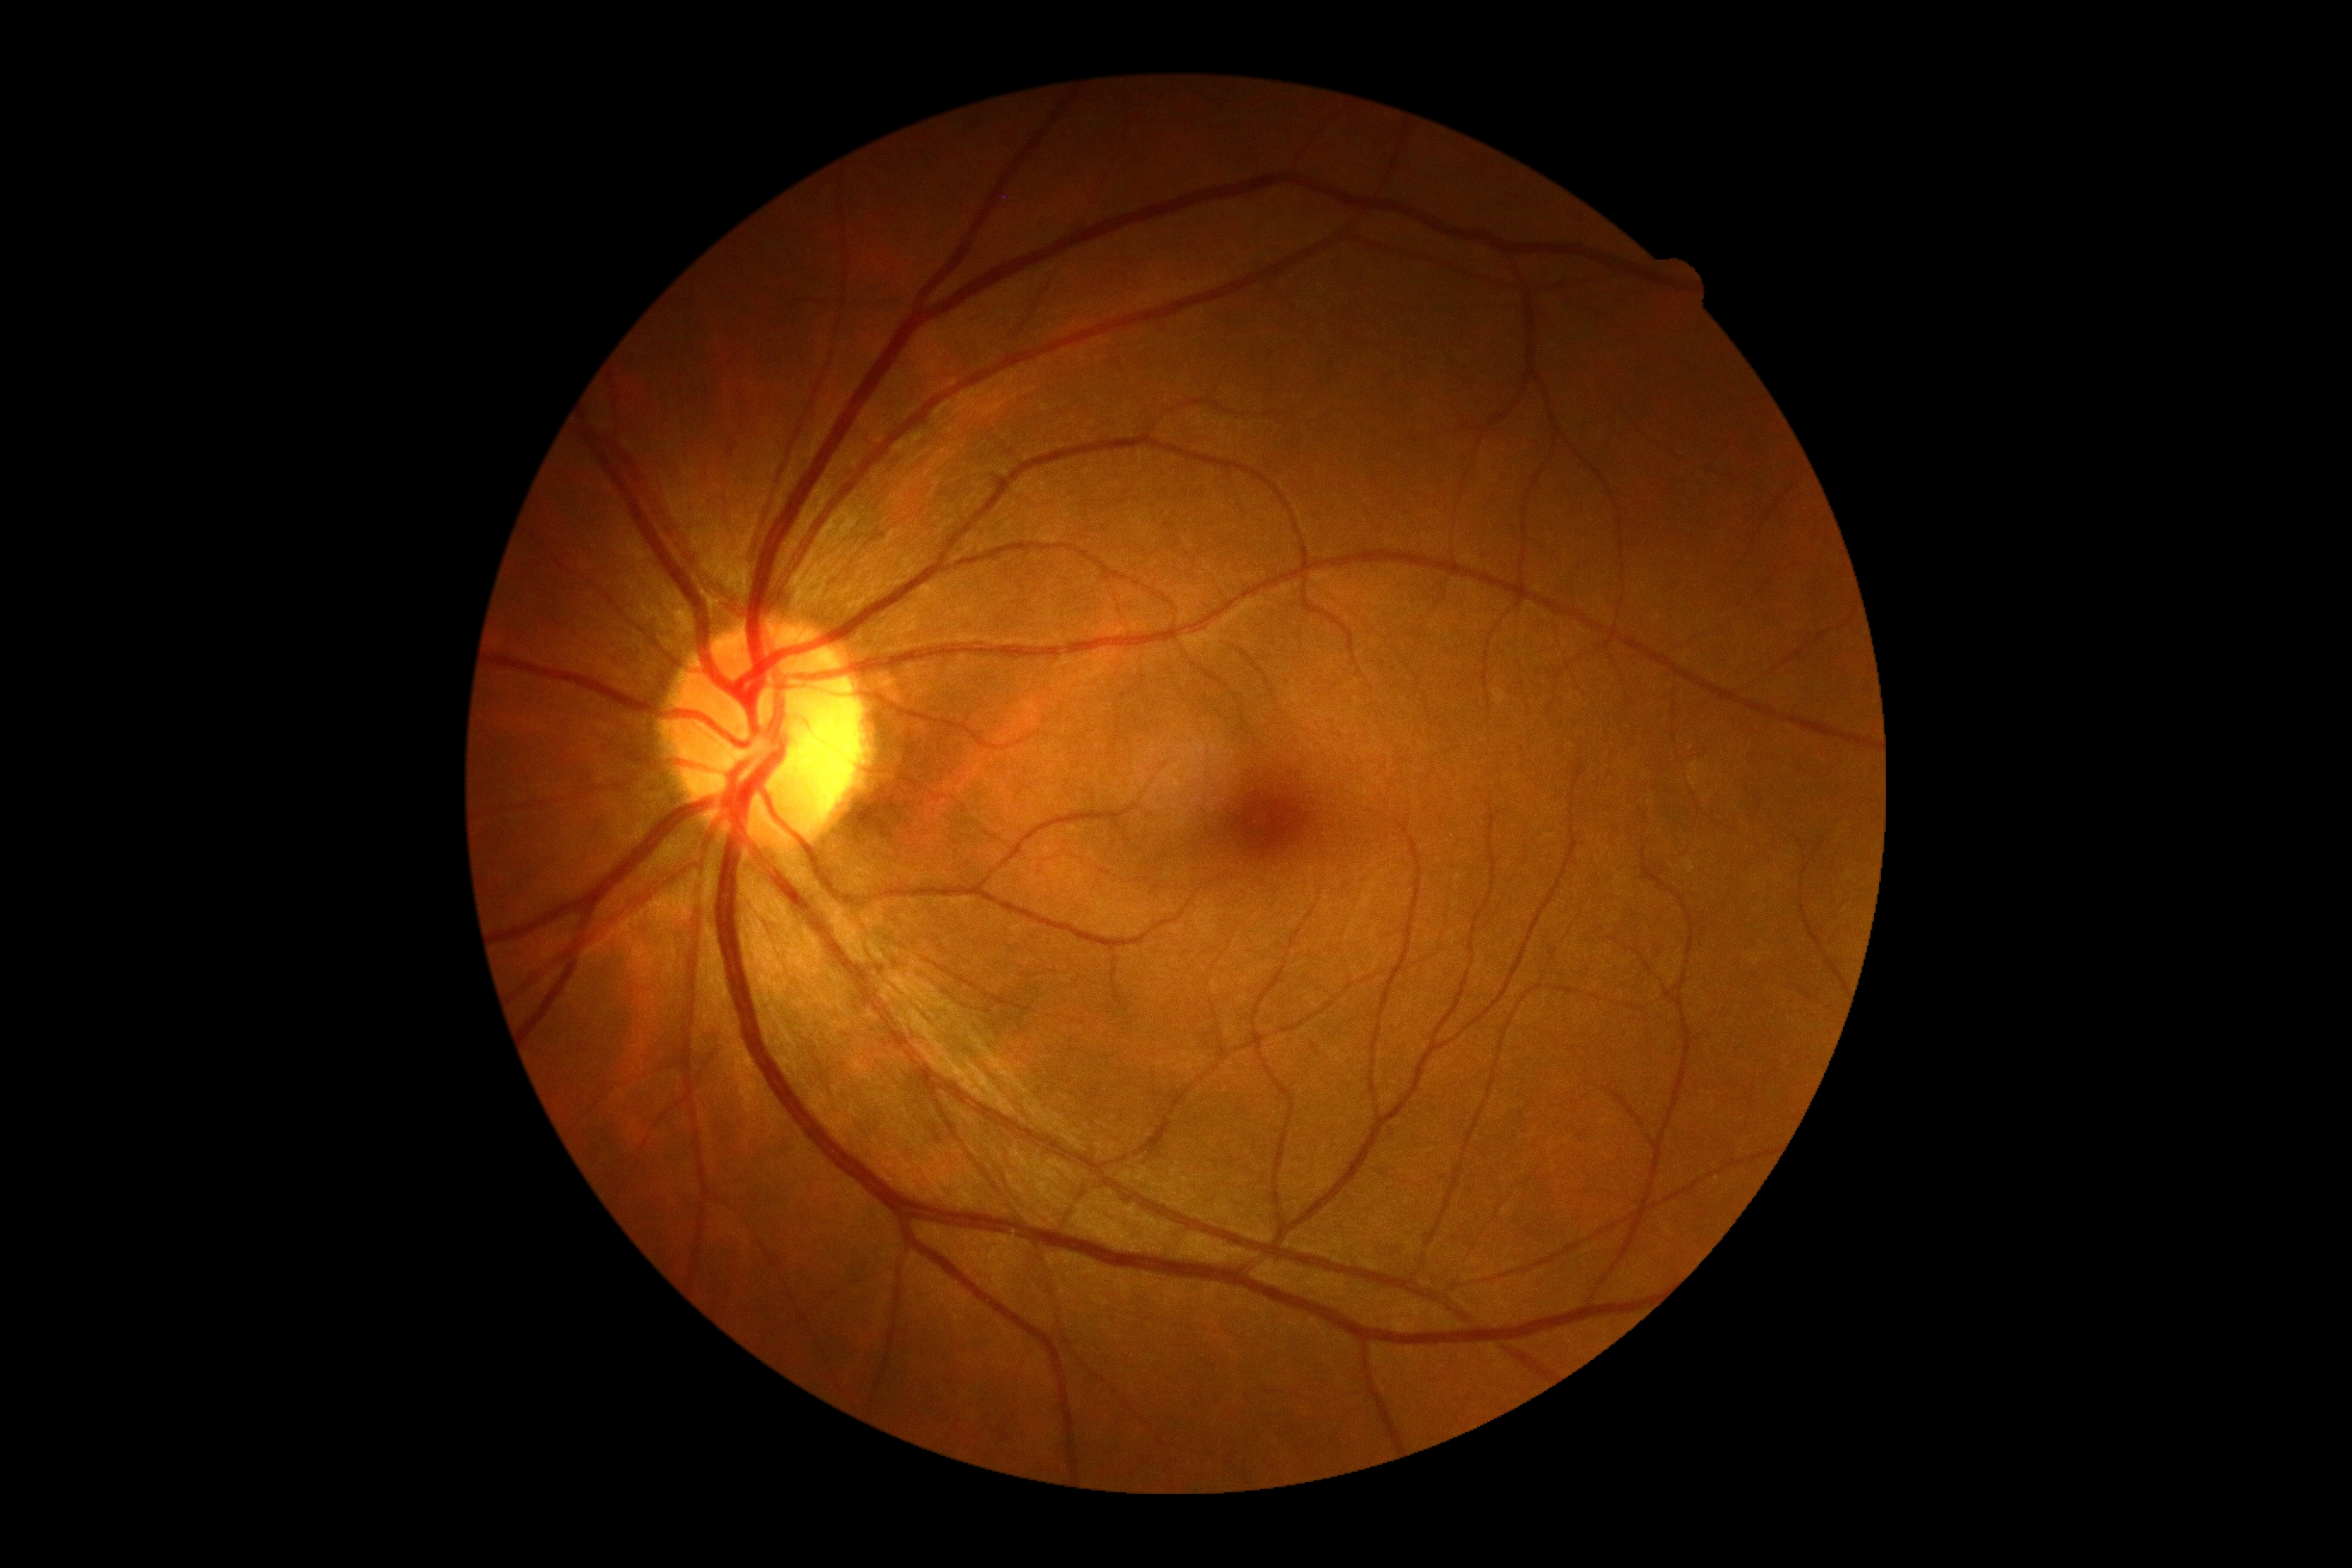

Diabetic retinopathy (DR): grade 0 (no apparent retinopathy).